Macula-centered. 1932 x 1932 pixels. Captured after pupil dilation
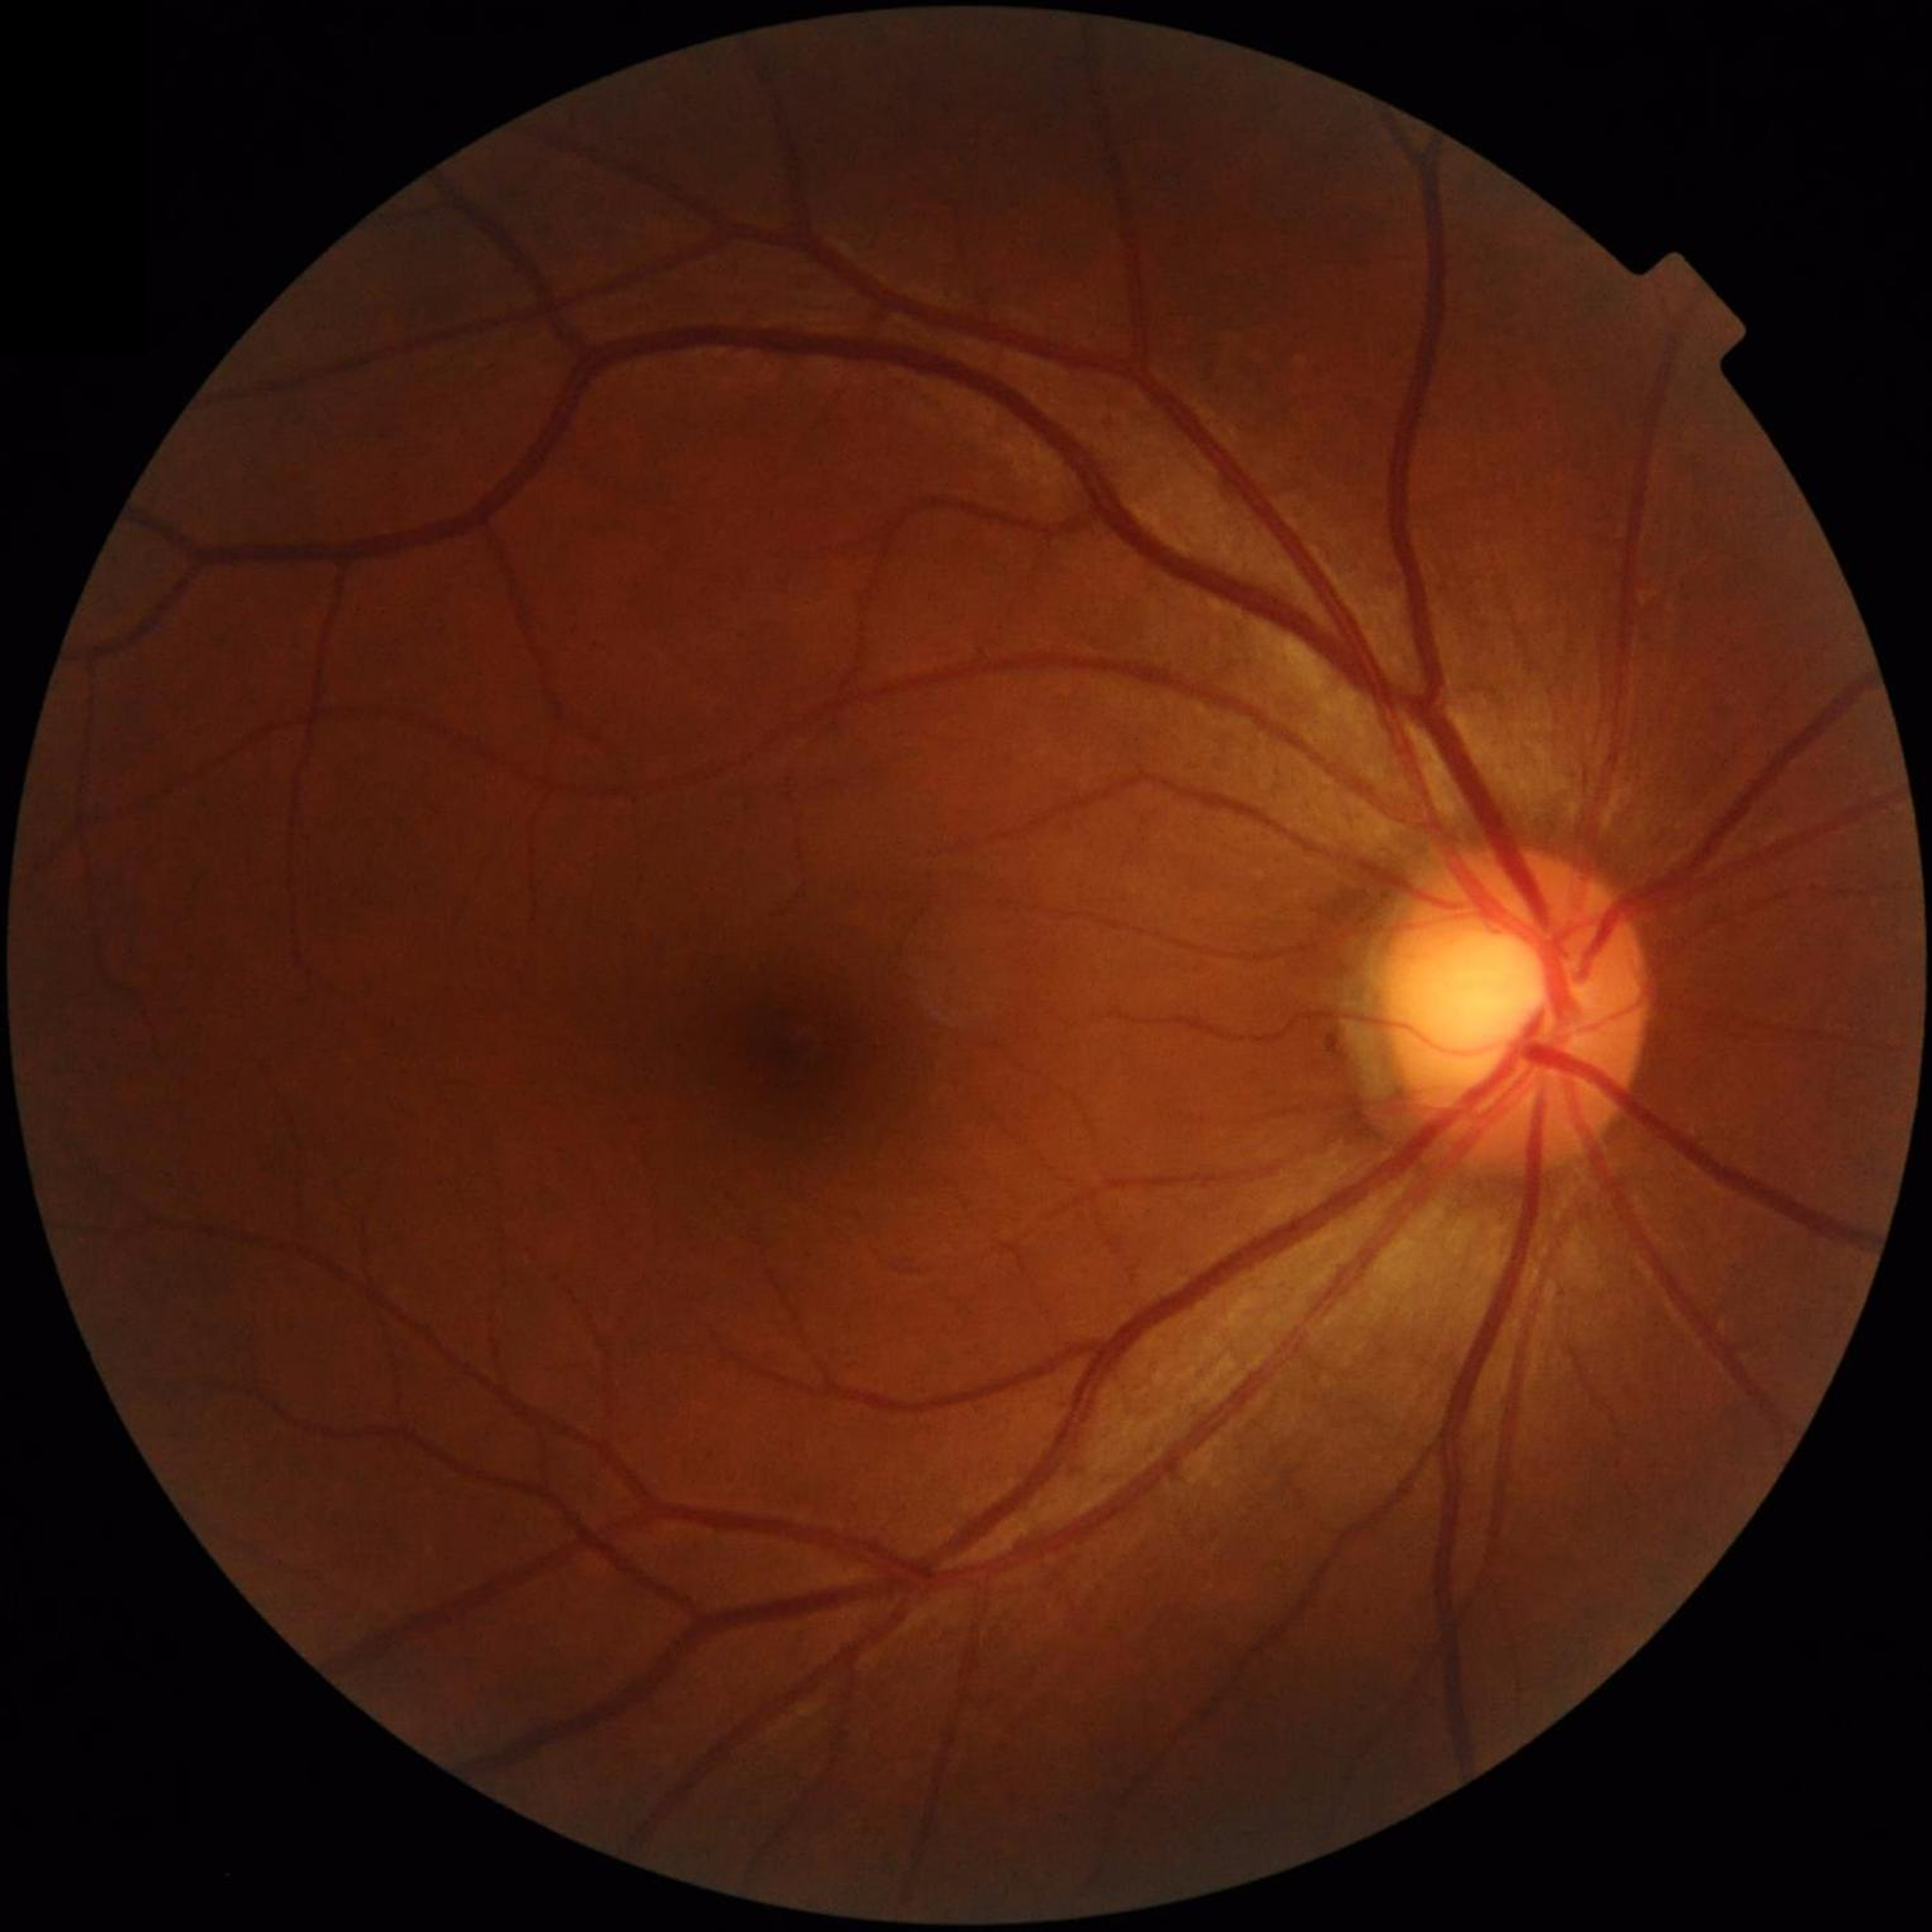 Photo quality: satisfactory. Fundus image with no AMD, diabetic retinopathy, or glaucomatous findings.